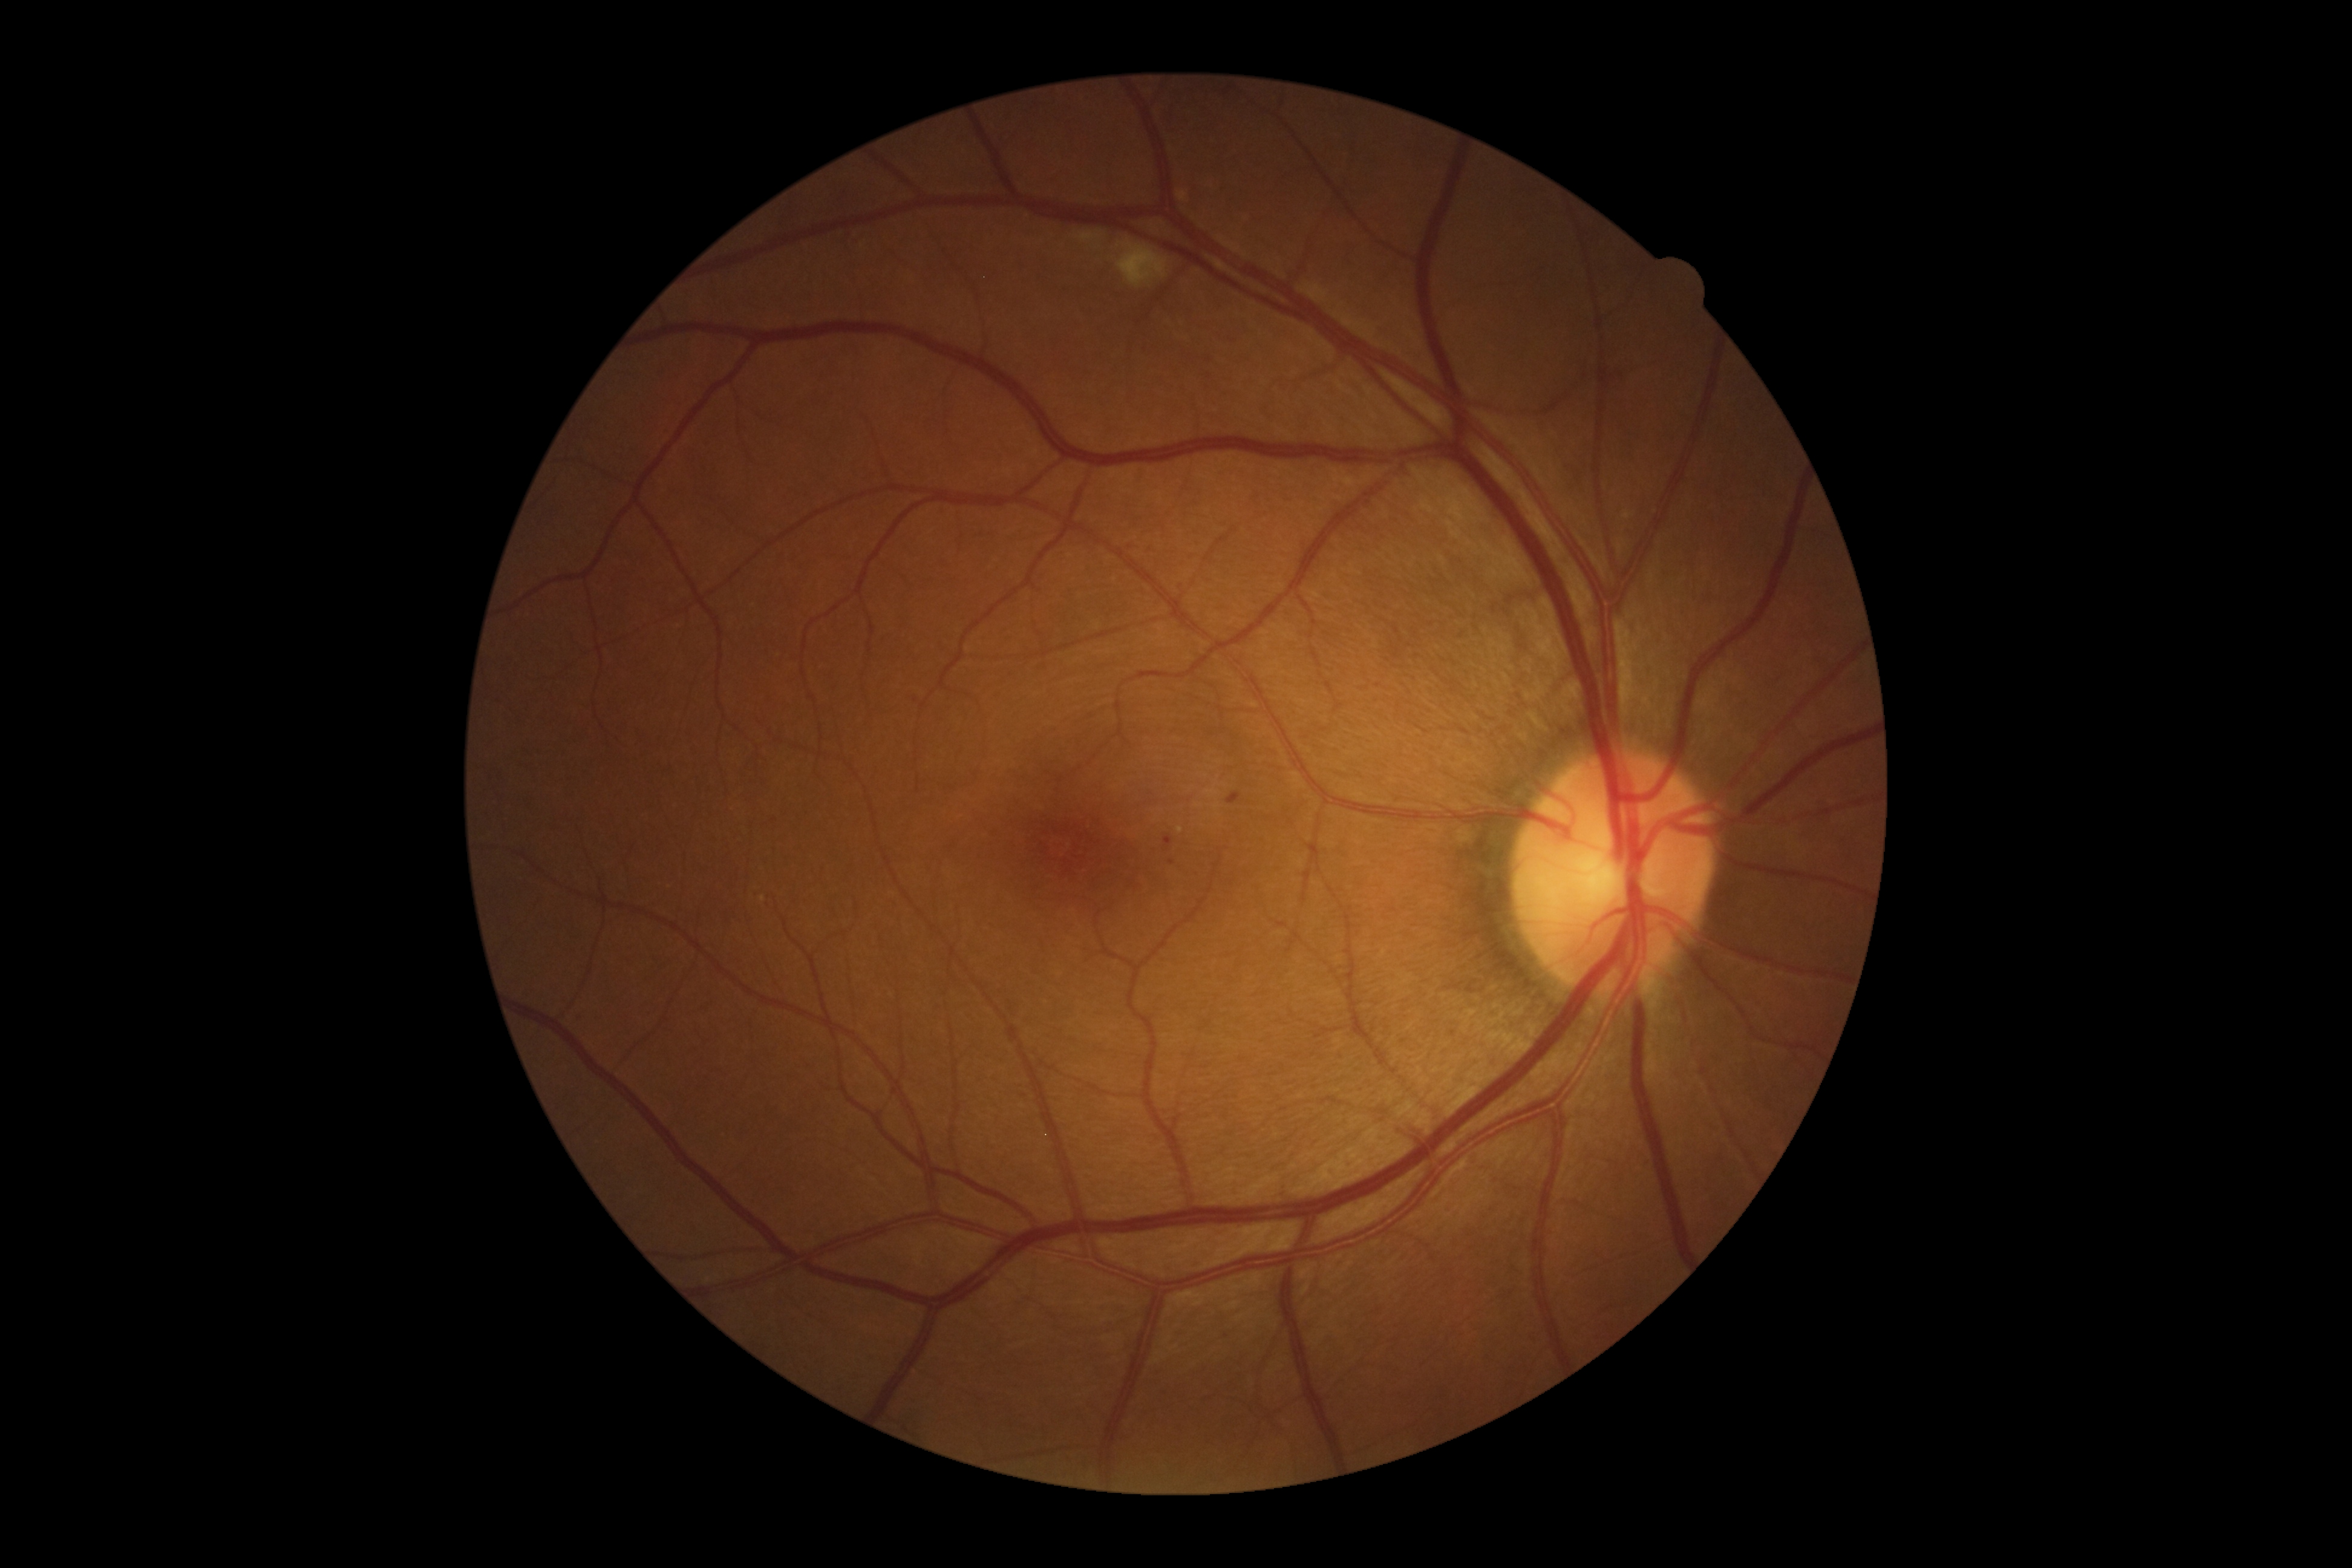 DR stage is grade 2 (moderate NPDR).